RetCam wide-field infant fundus image:
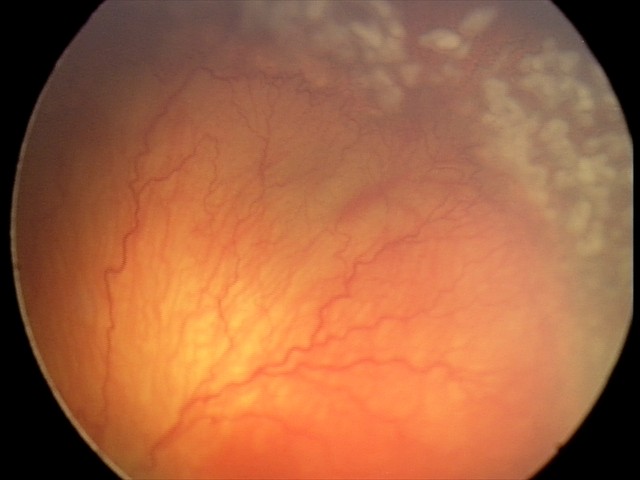

Plus disease present. Examination diagnosed as aggressive retinopathy of prematurity.